848 x 848 pixels — 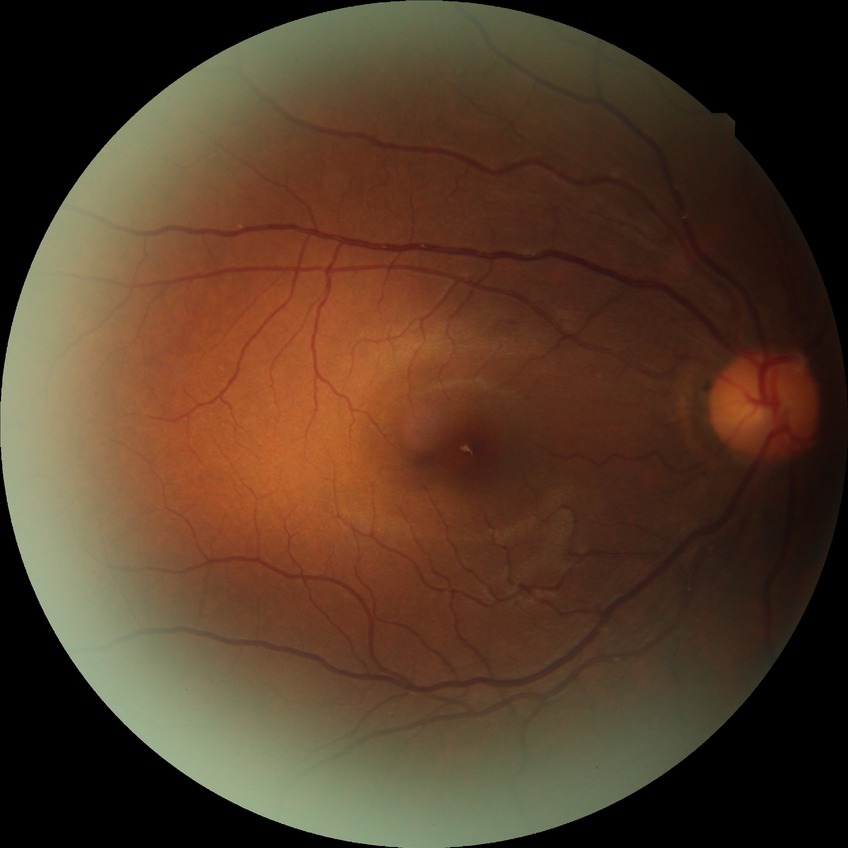 Davis DR grade is NDR. No diabetic retinal disease findings.